2212 by 1659 pixels. 45° FOV
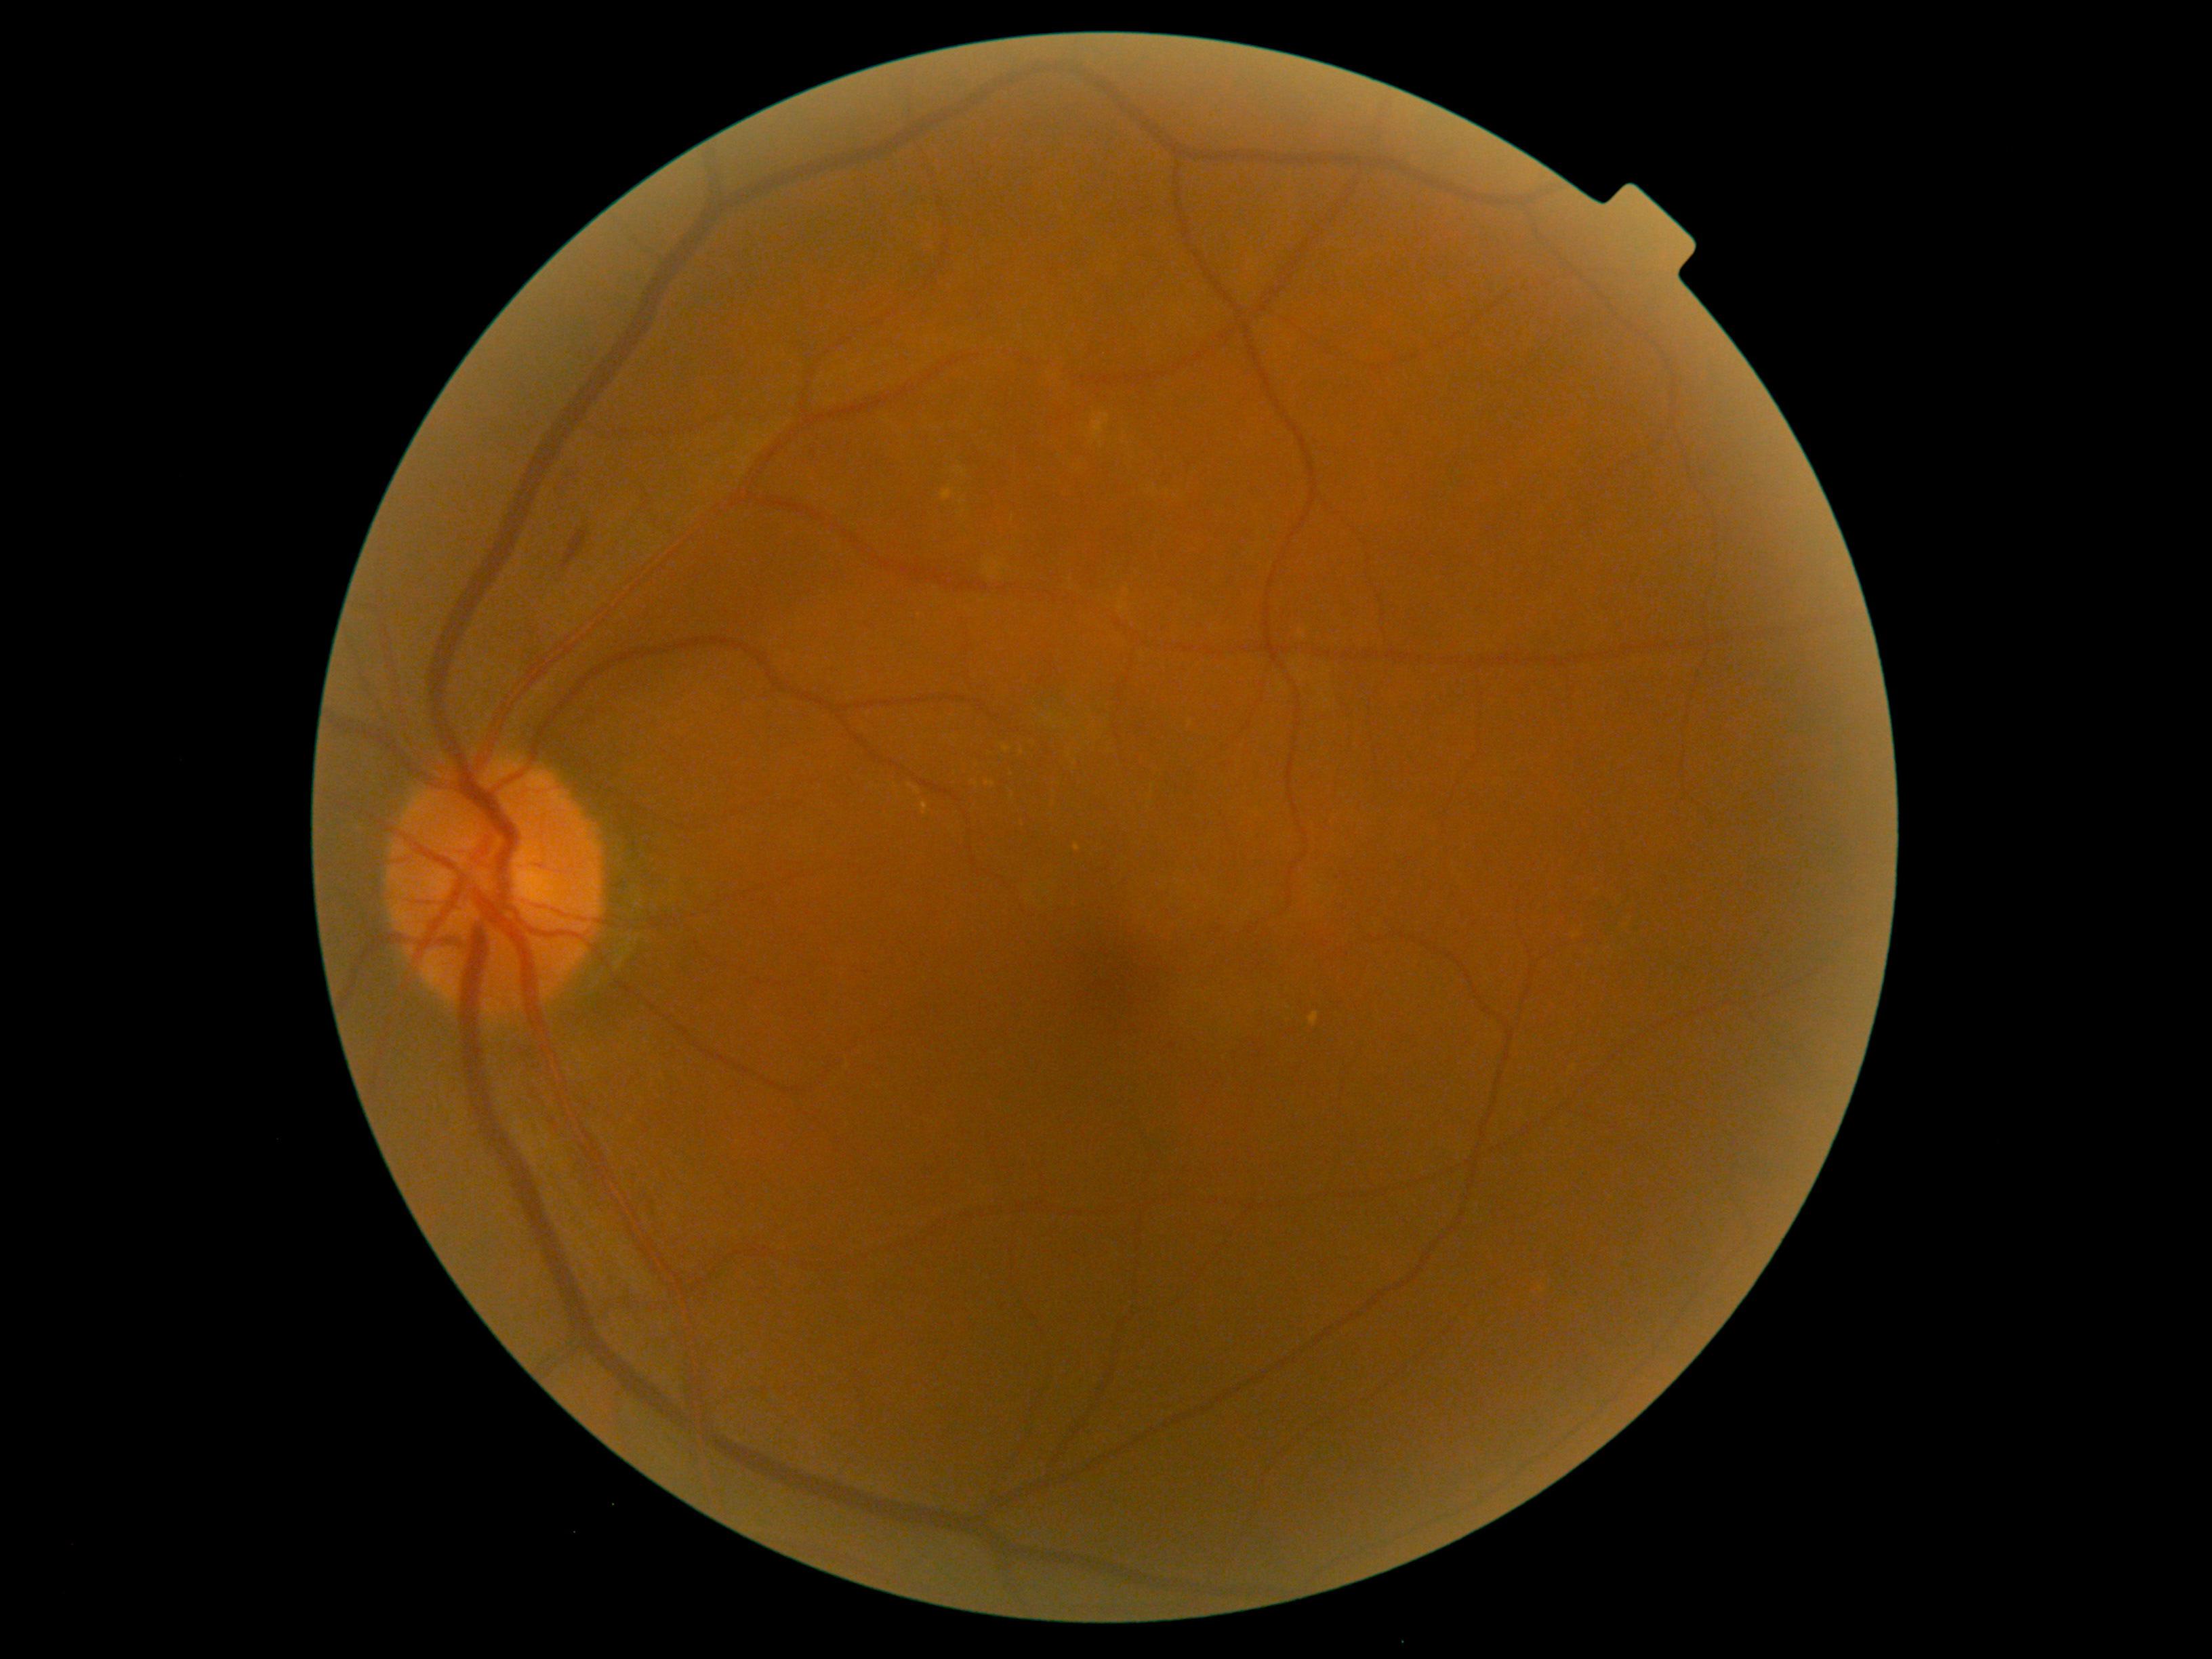 Annotations:
* DR: grade 2